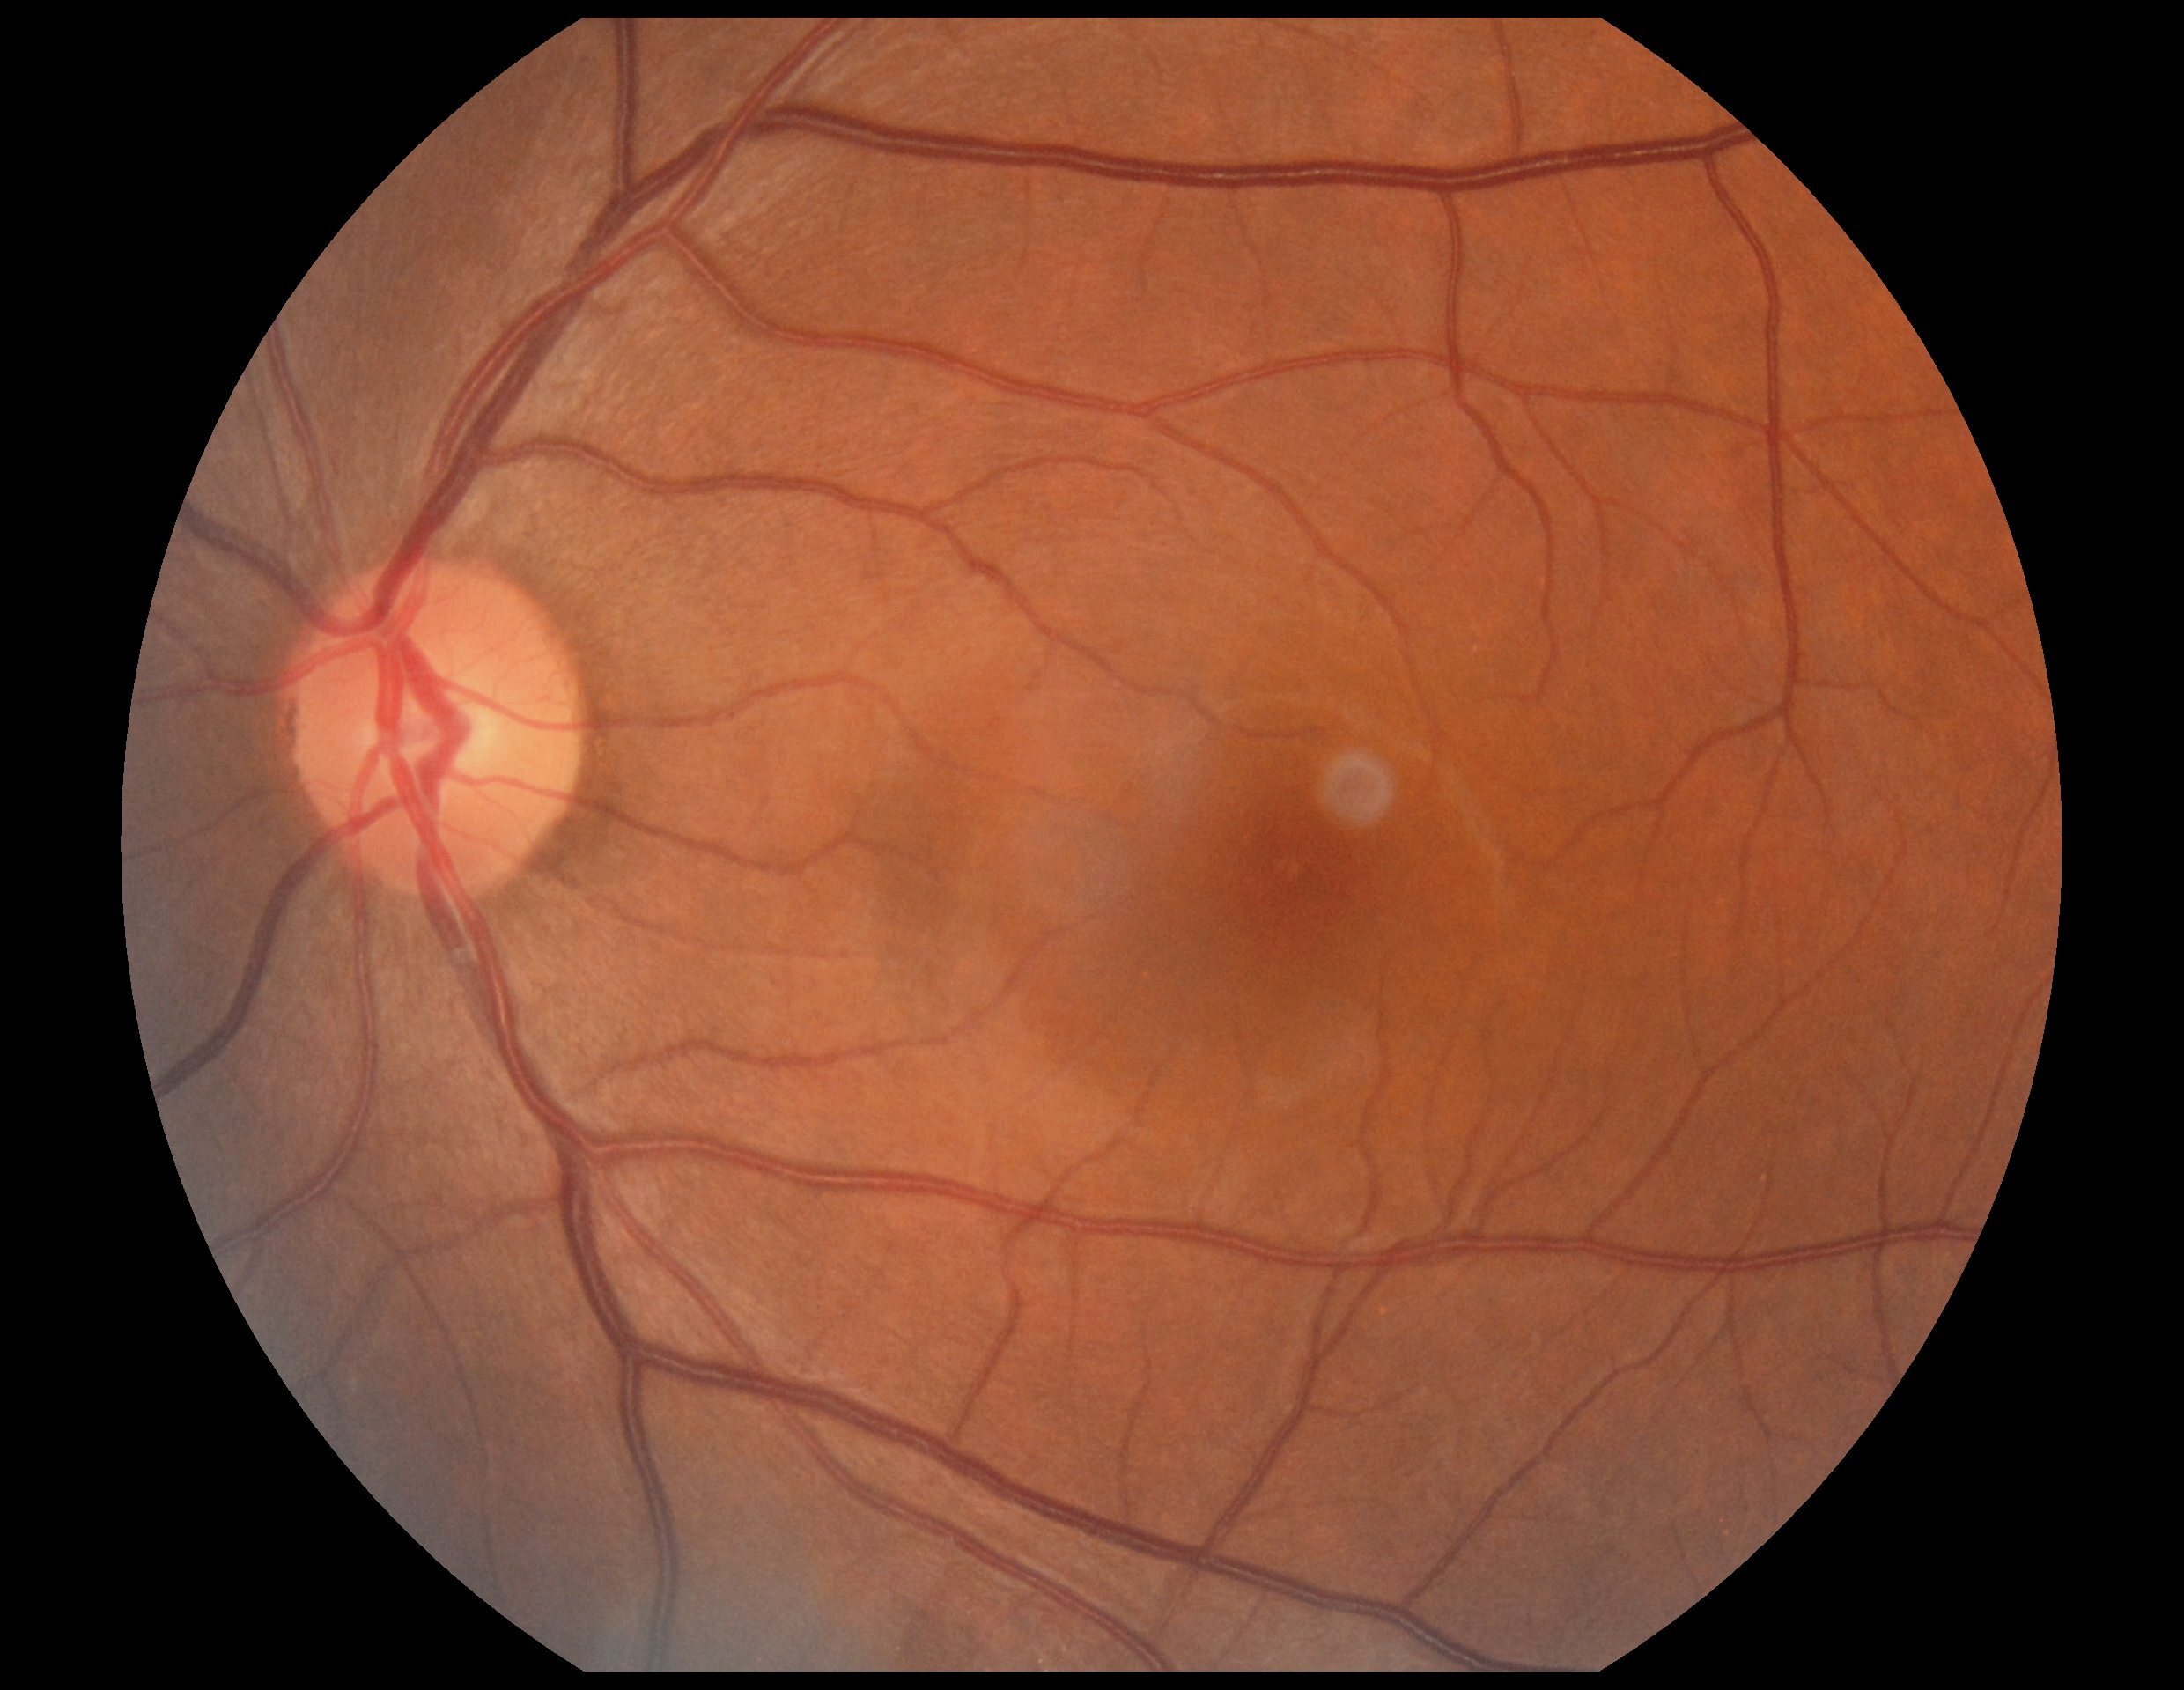
diabetic retinopathy: grade 0 (no apparent retinopathy)